CFP — 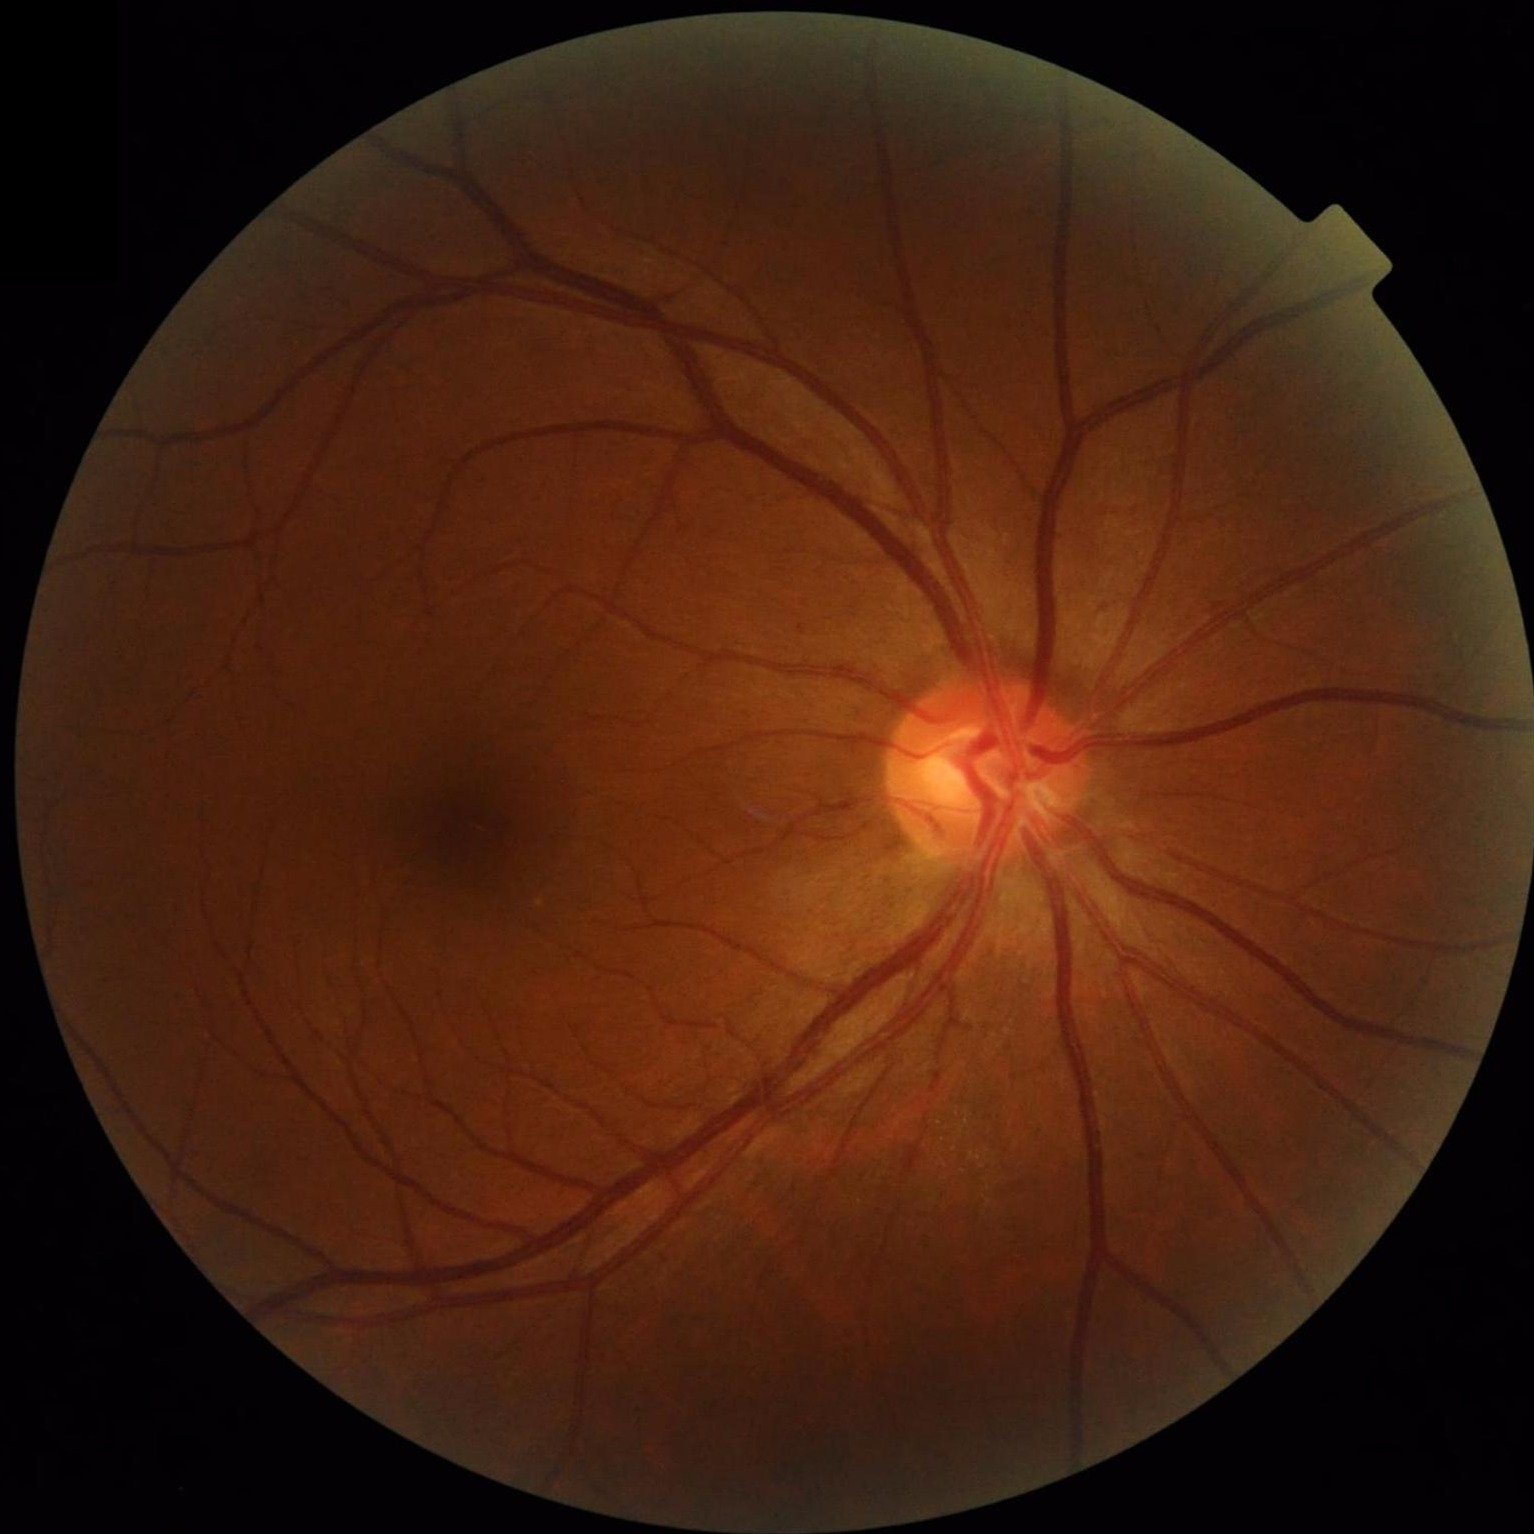

Quality grading: sharpness: optic disc, vessels, and background in focus | contrast: good dynamic range | overall: good, gradable.